Image size 2212x1659 · portable fundus camera image — 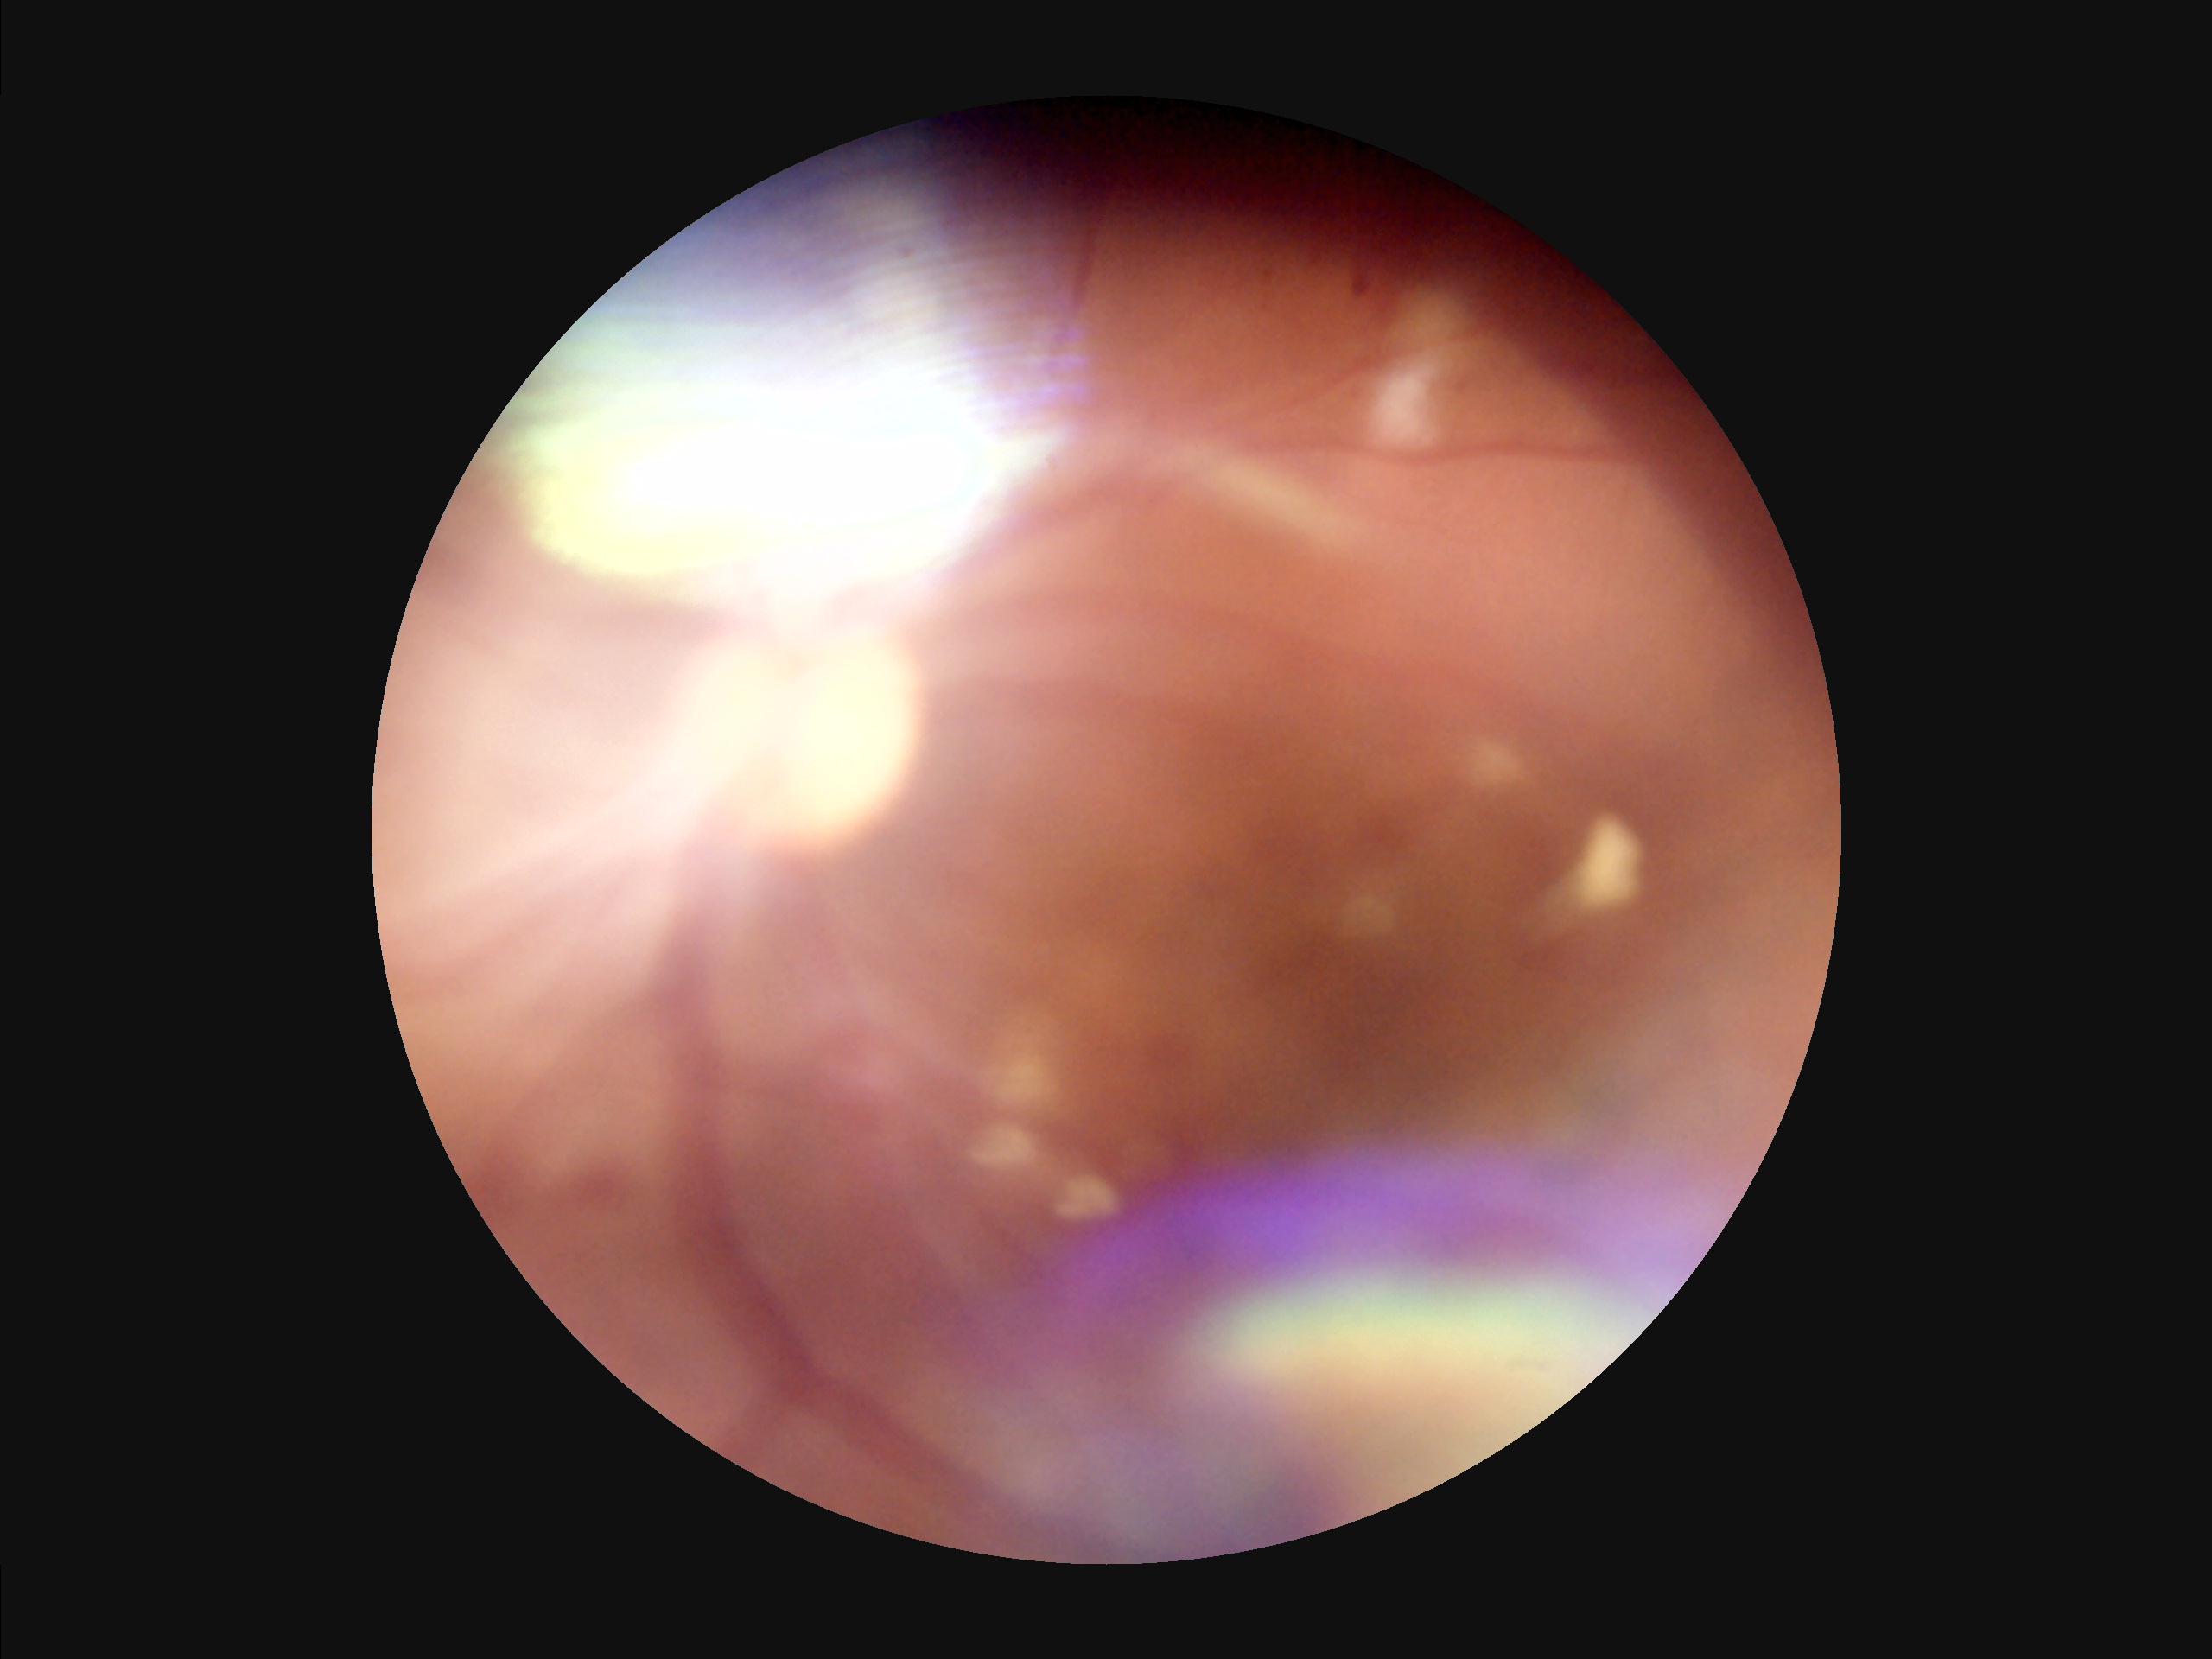
There is over- or under-exposure or a color cast. Reduced sharpness with visible blur. Narrow intensity range; structures are hard to distinguish. Image quality is suboptimal.